Retinal fundus photograph.
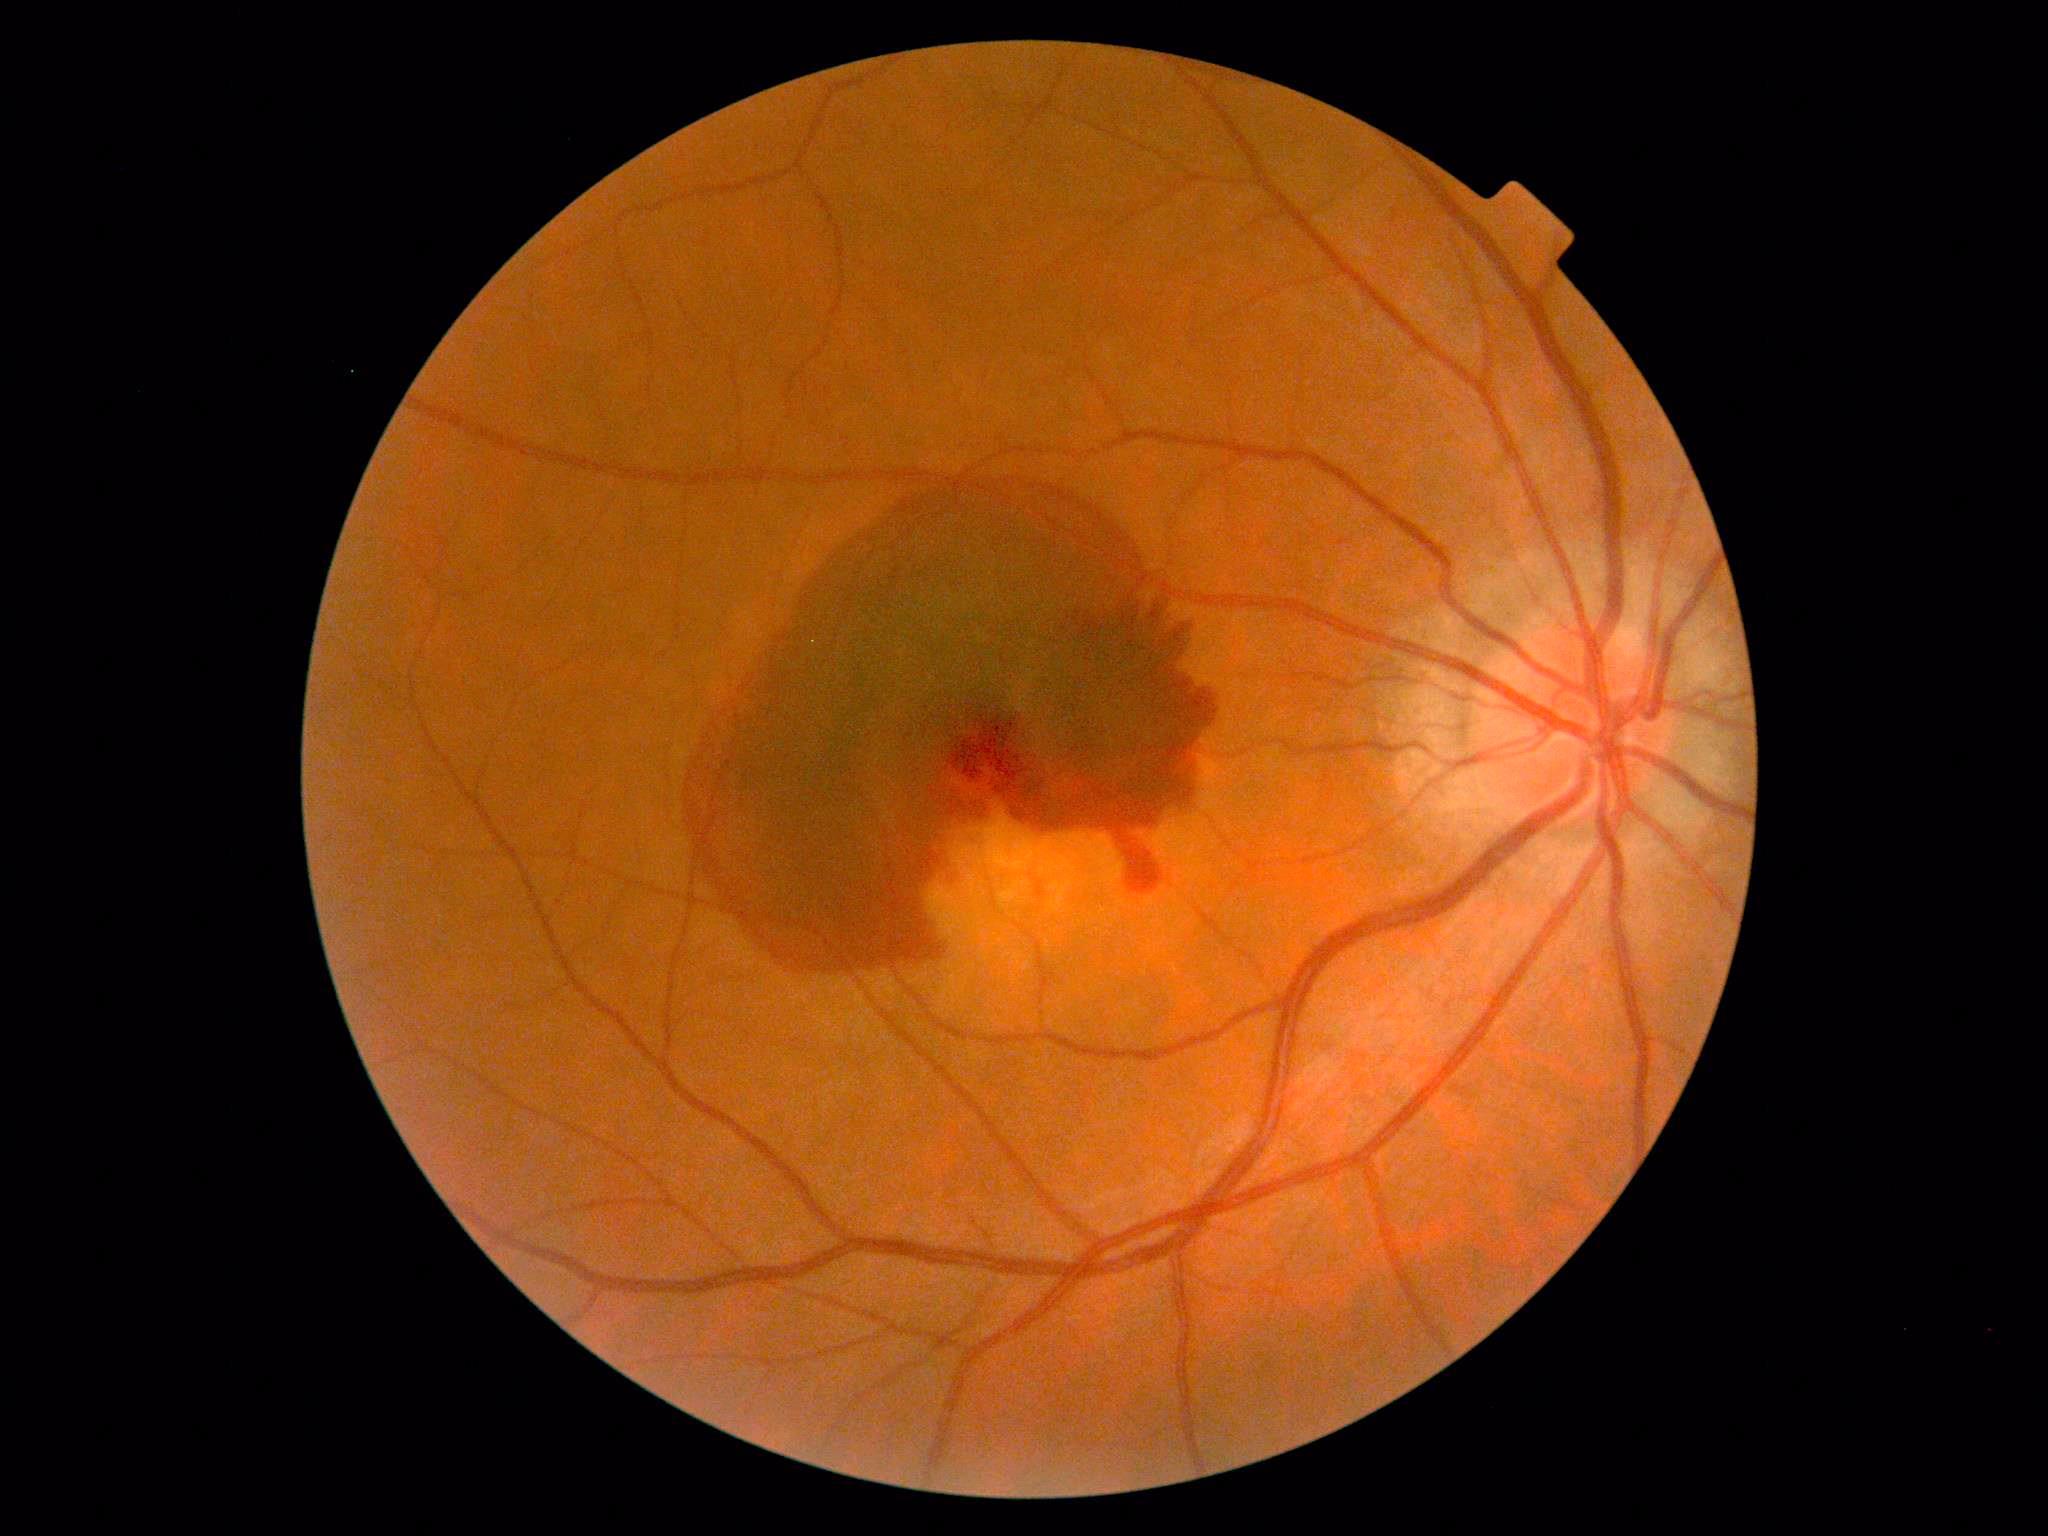
The retinopathy is classified as proliferative diabetic retinopathy. DR stage is proliferative diabetic retinopathy (grade 4).